45° FOV. Color fundus photograph:
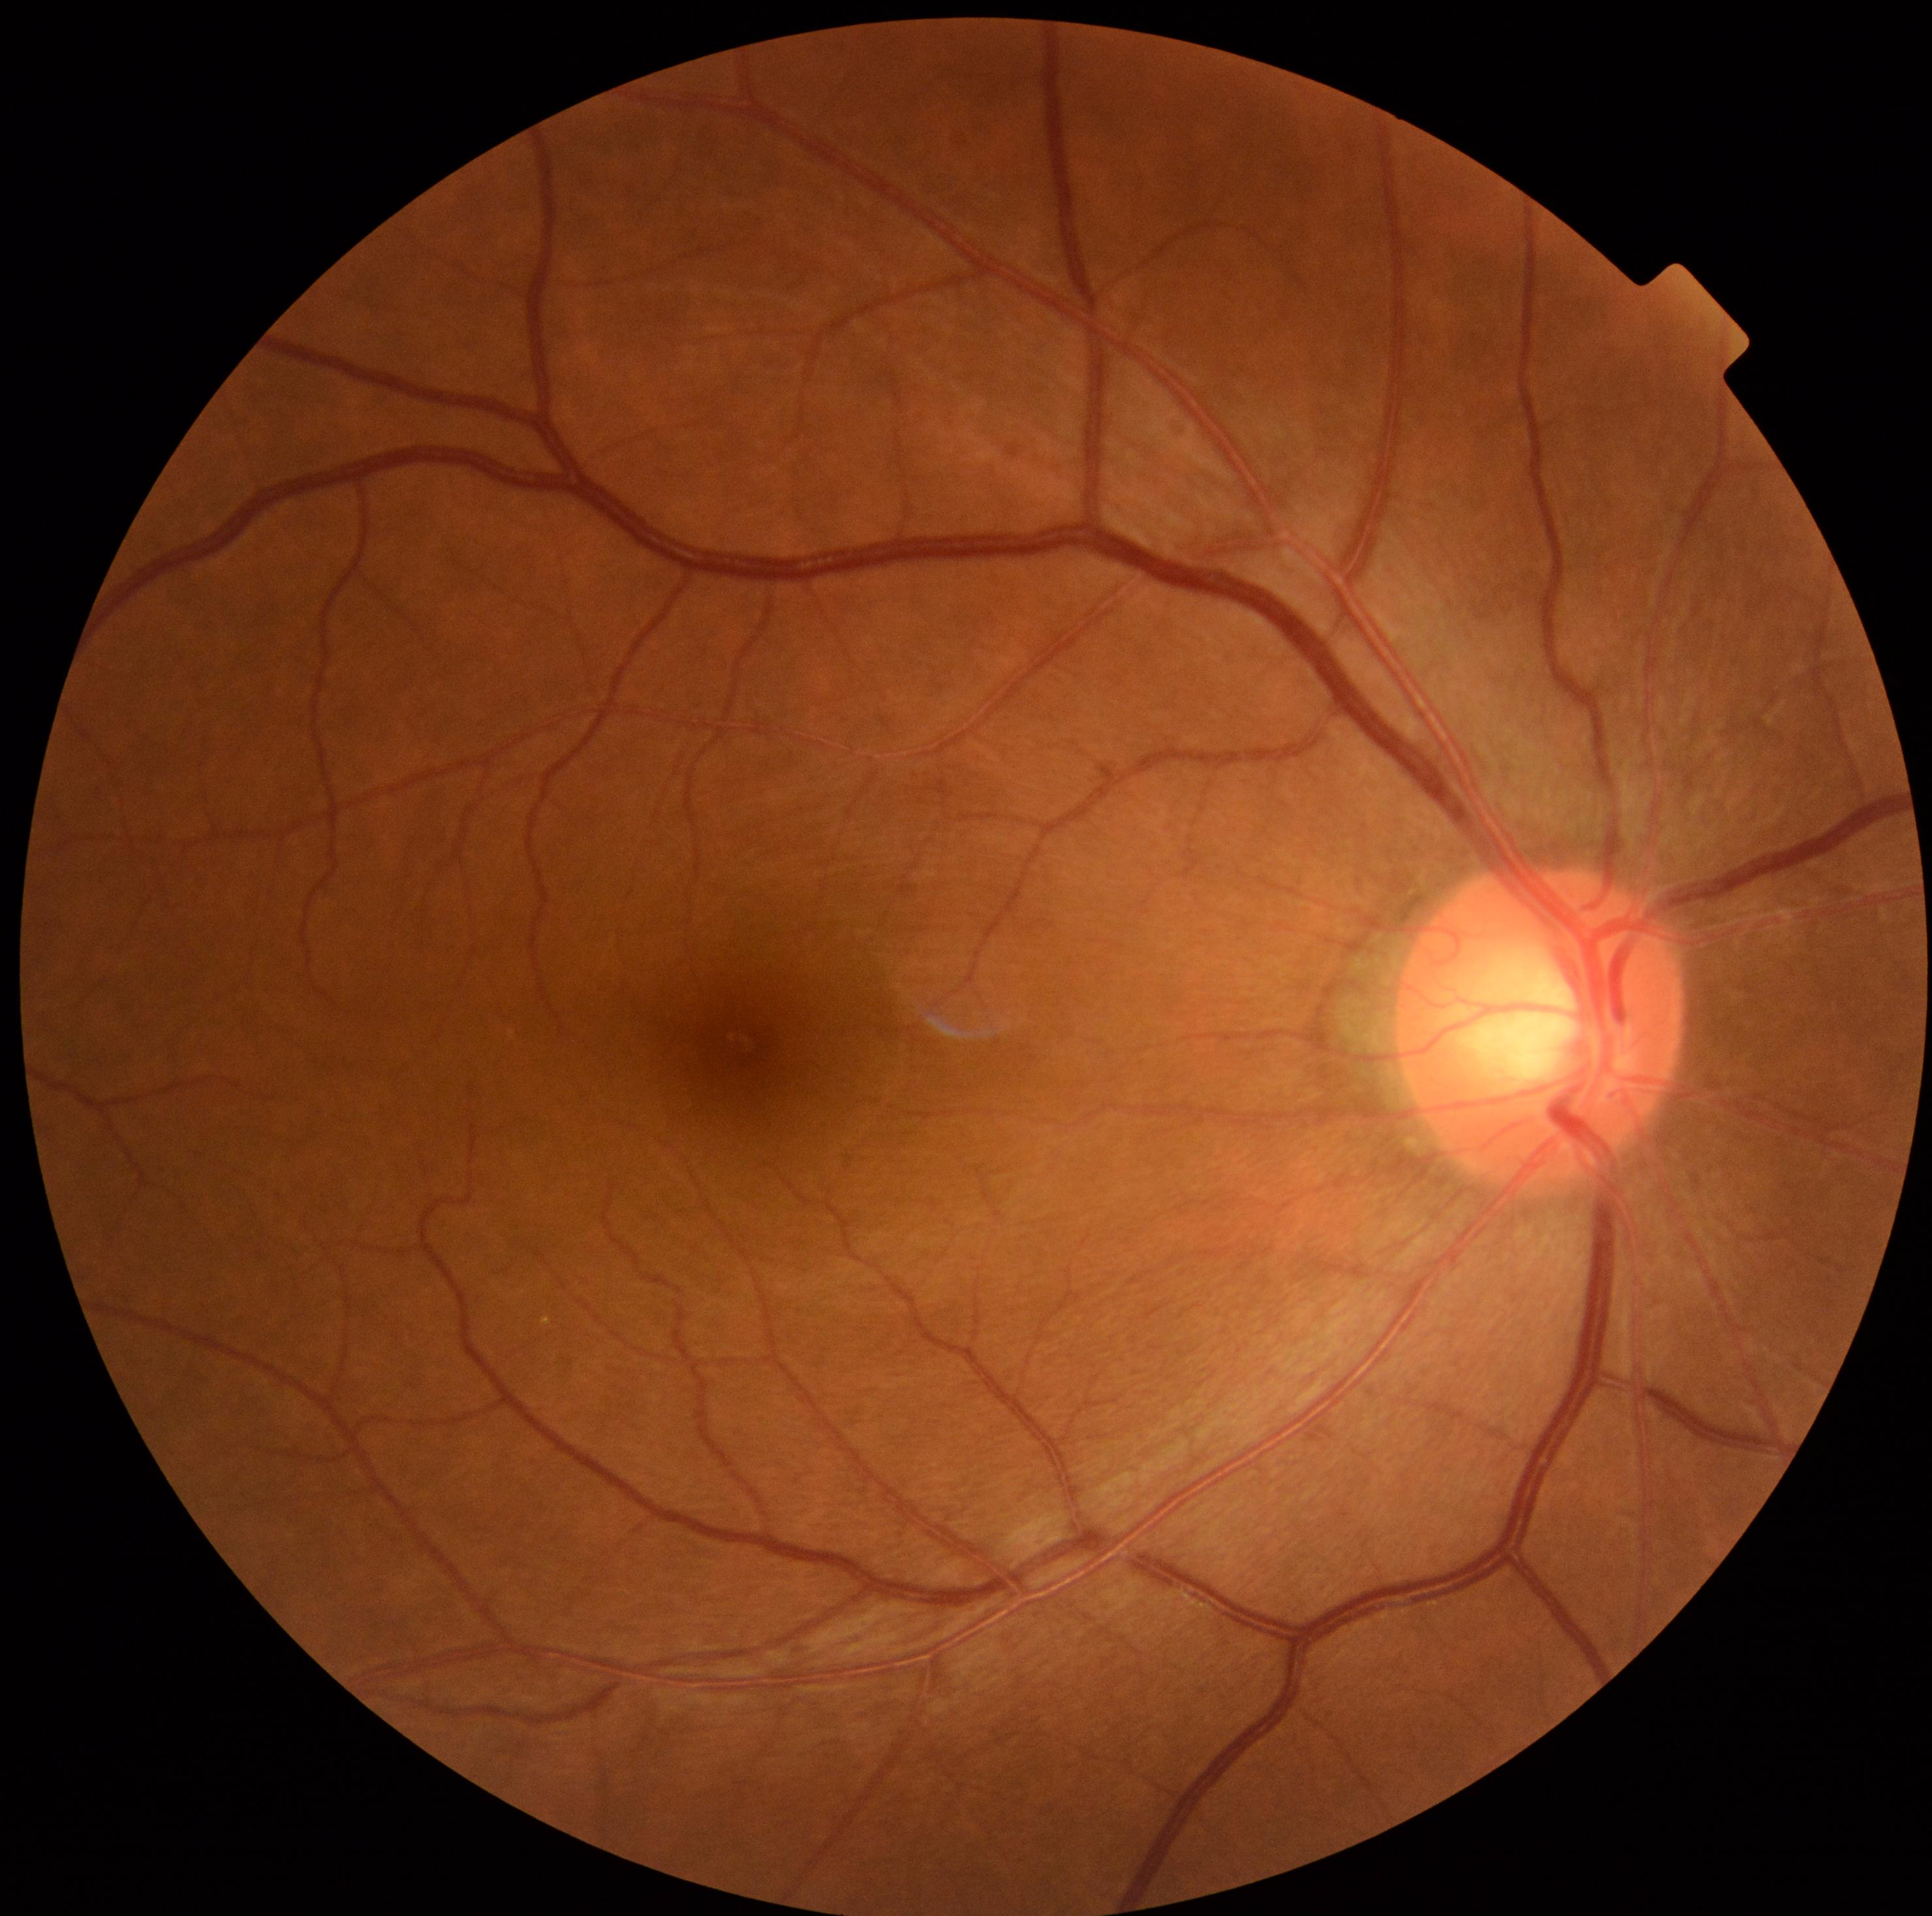 DR severity is 0/4.